45° FOV — 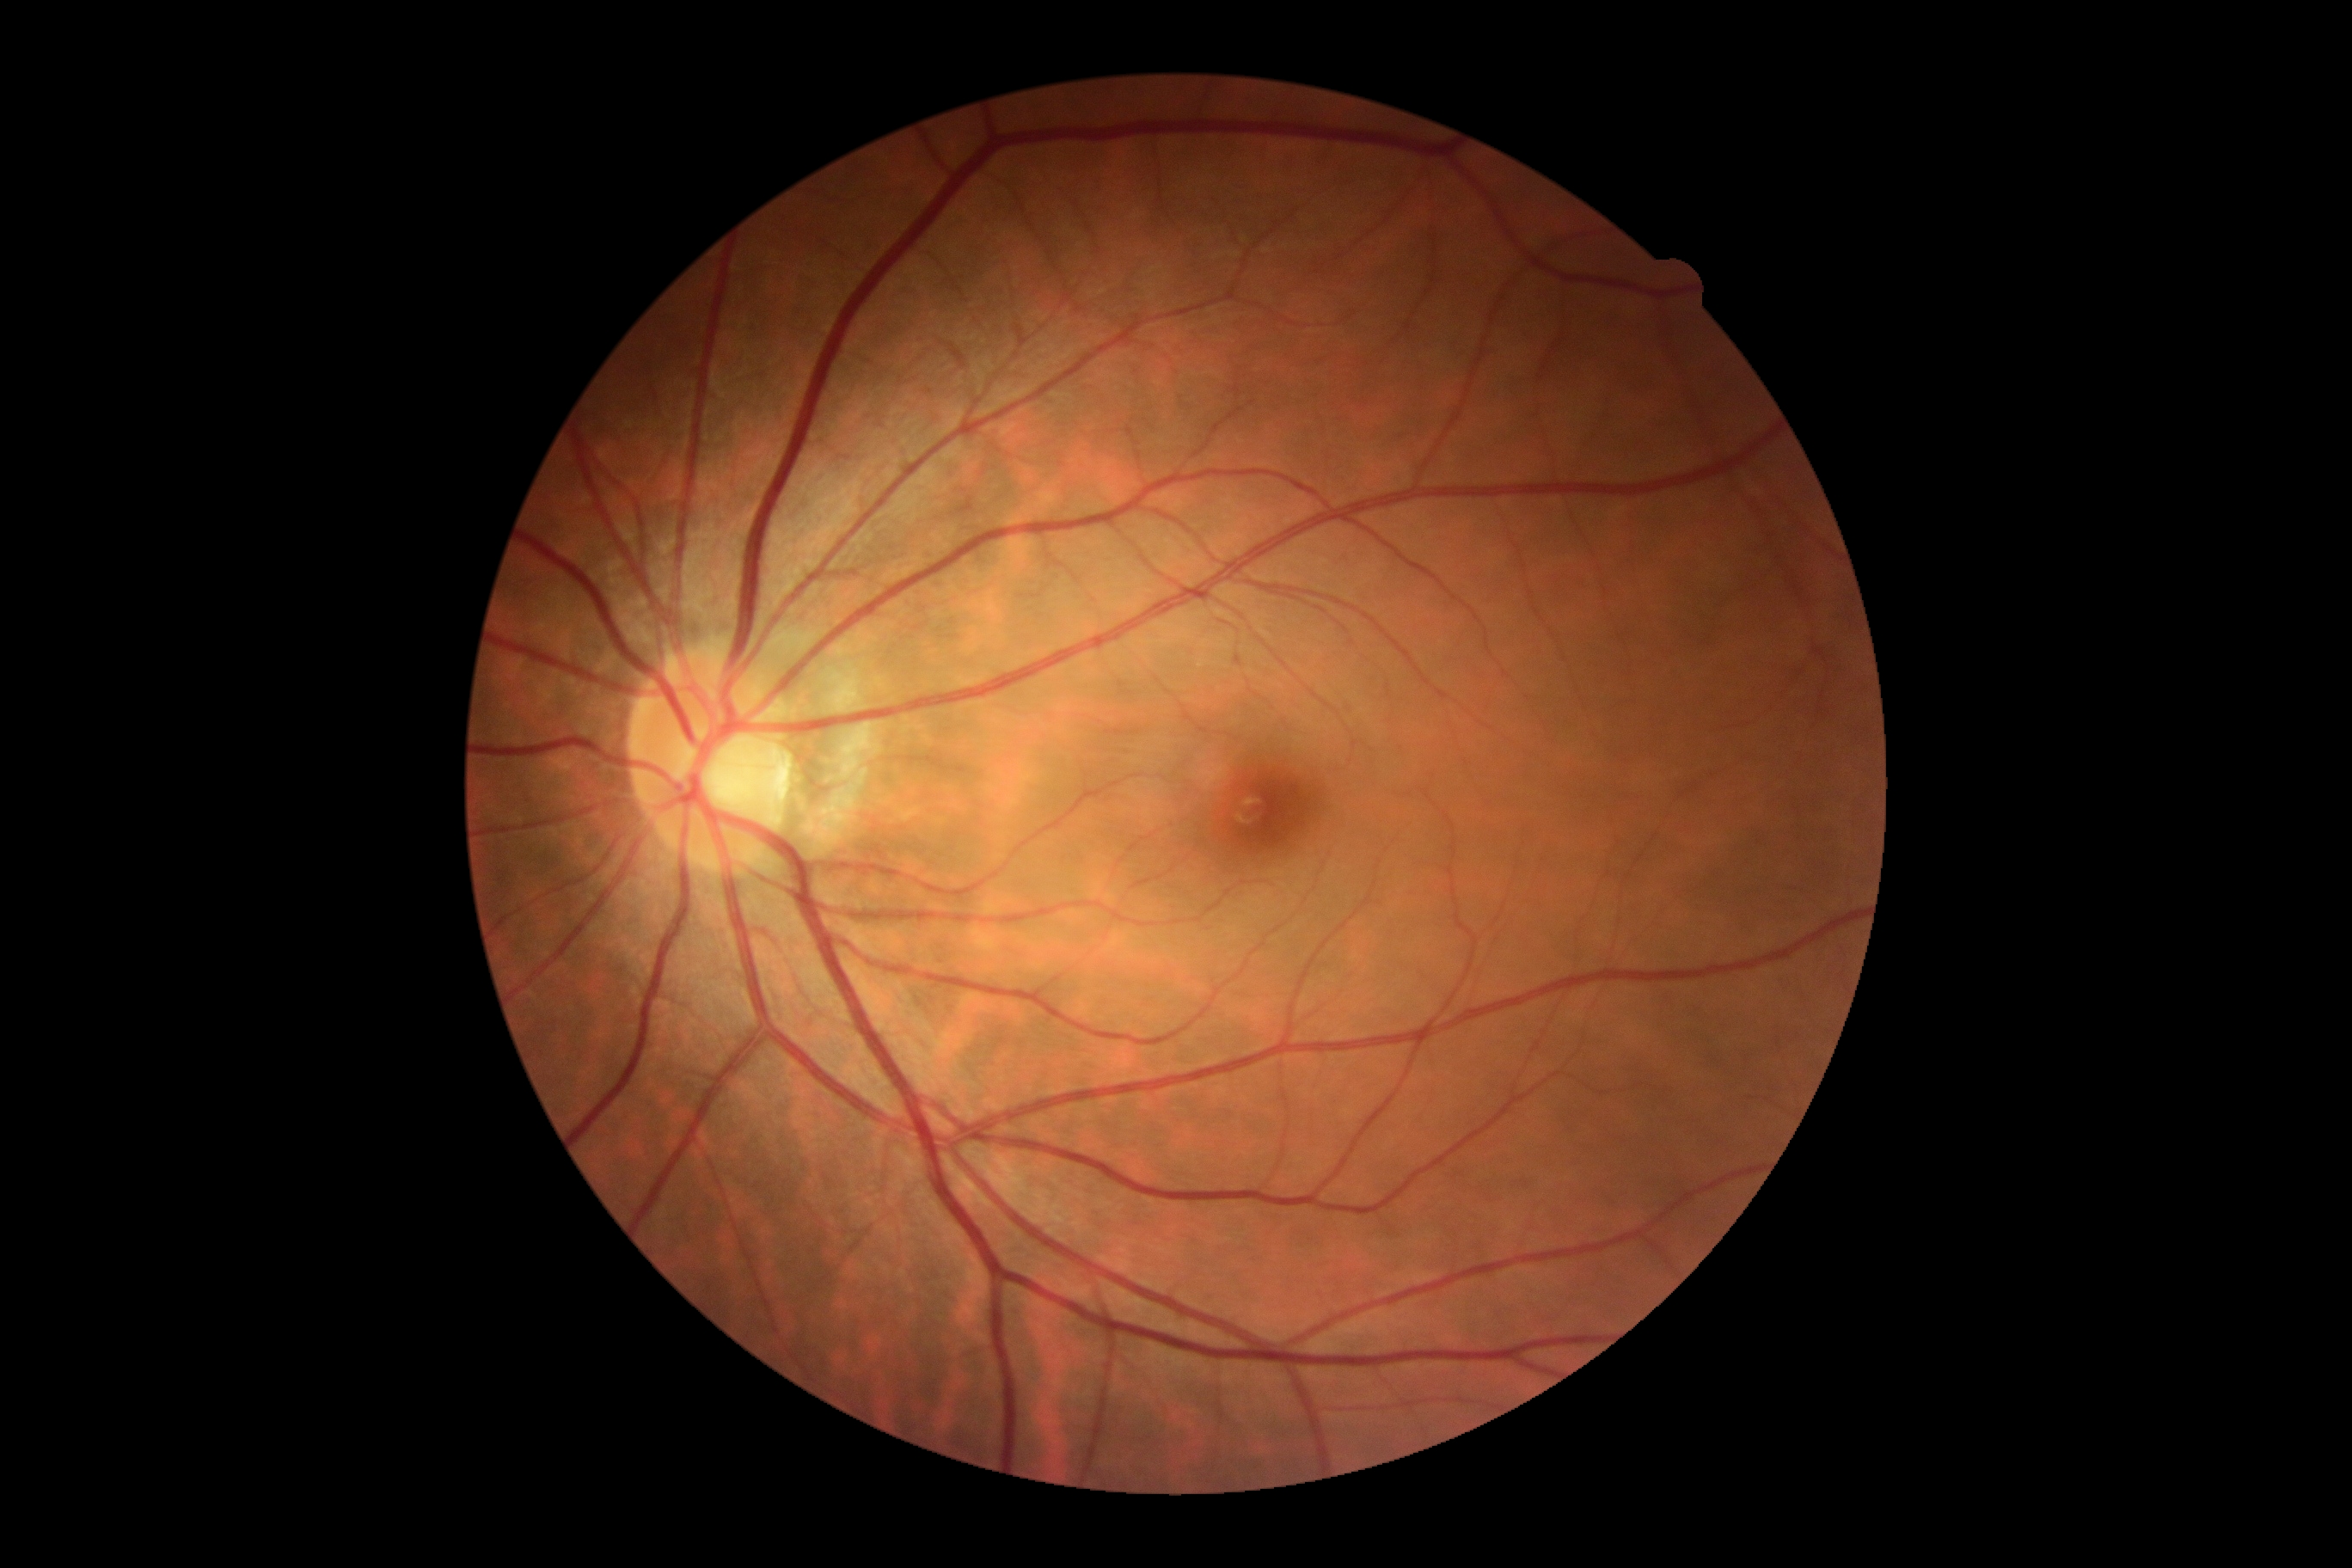

DR=no apparent retinopathy (grade 0).